848 by 848 pixels. NIDEK AFC-230 fundus camera:
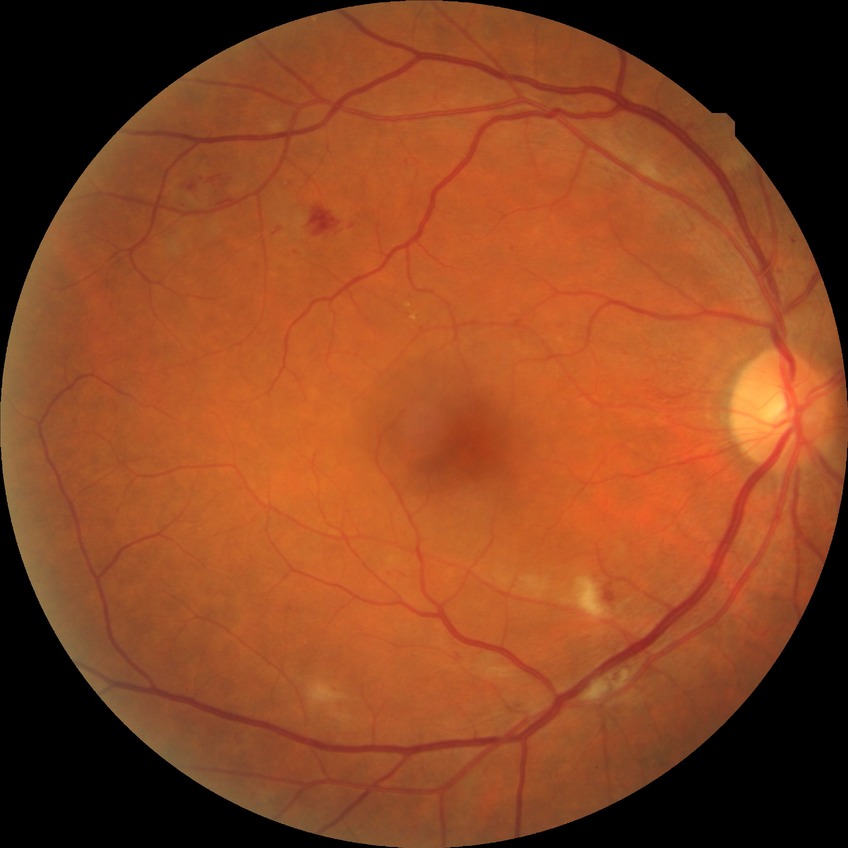 diabetic retinopathy (DR)@pre-proliferative diabetic retinopathy (PPDR).